Posterior pole color fundus photograph:
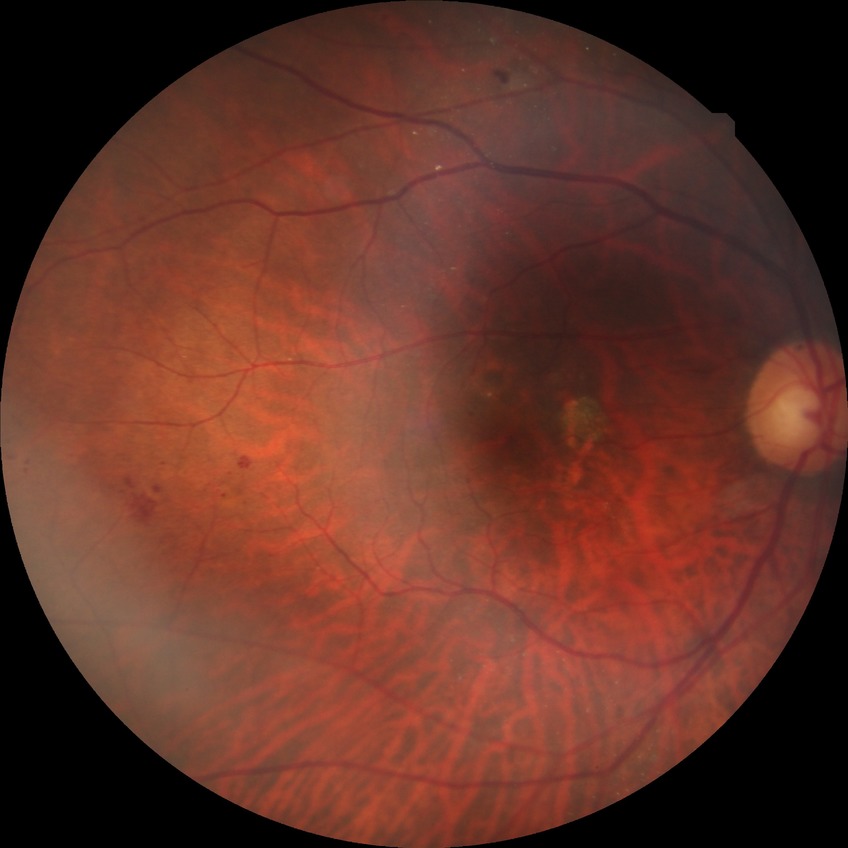

Diabetic retinopathy (DR) is NDR (no diabetic retinopathy).